Retinal fundus photograph: 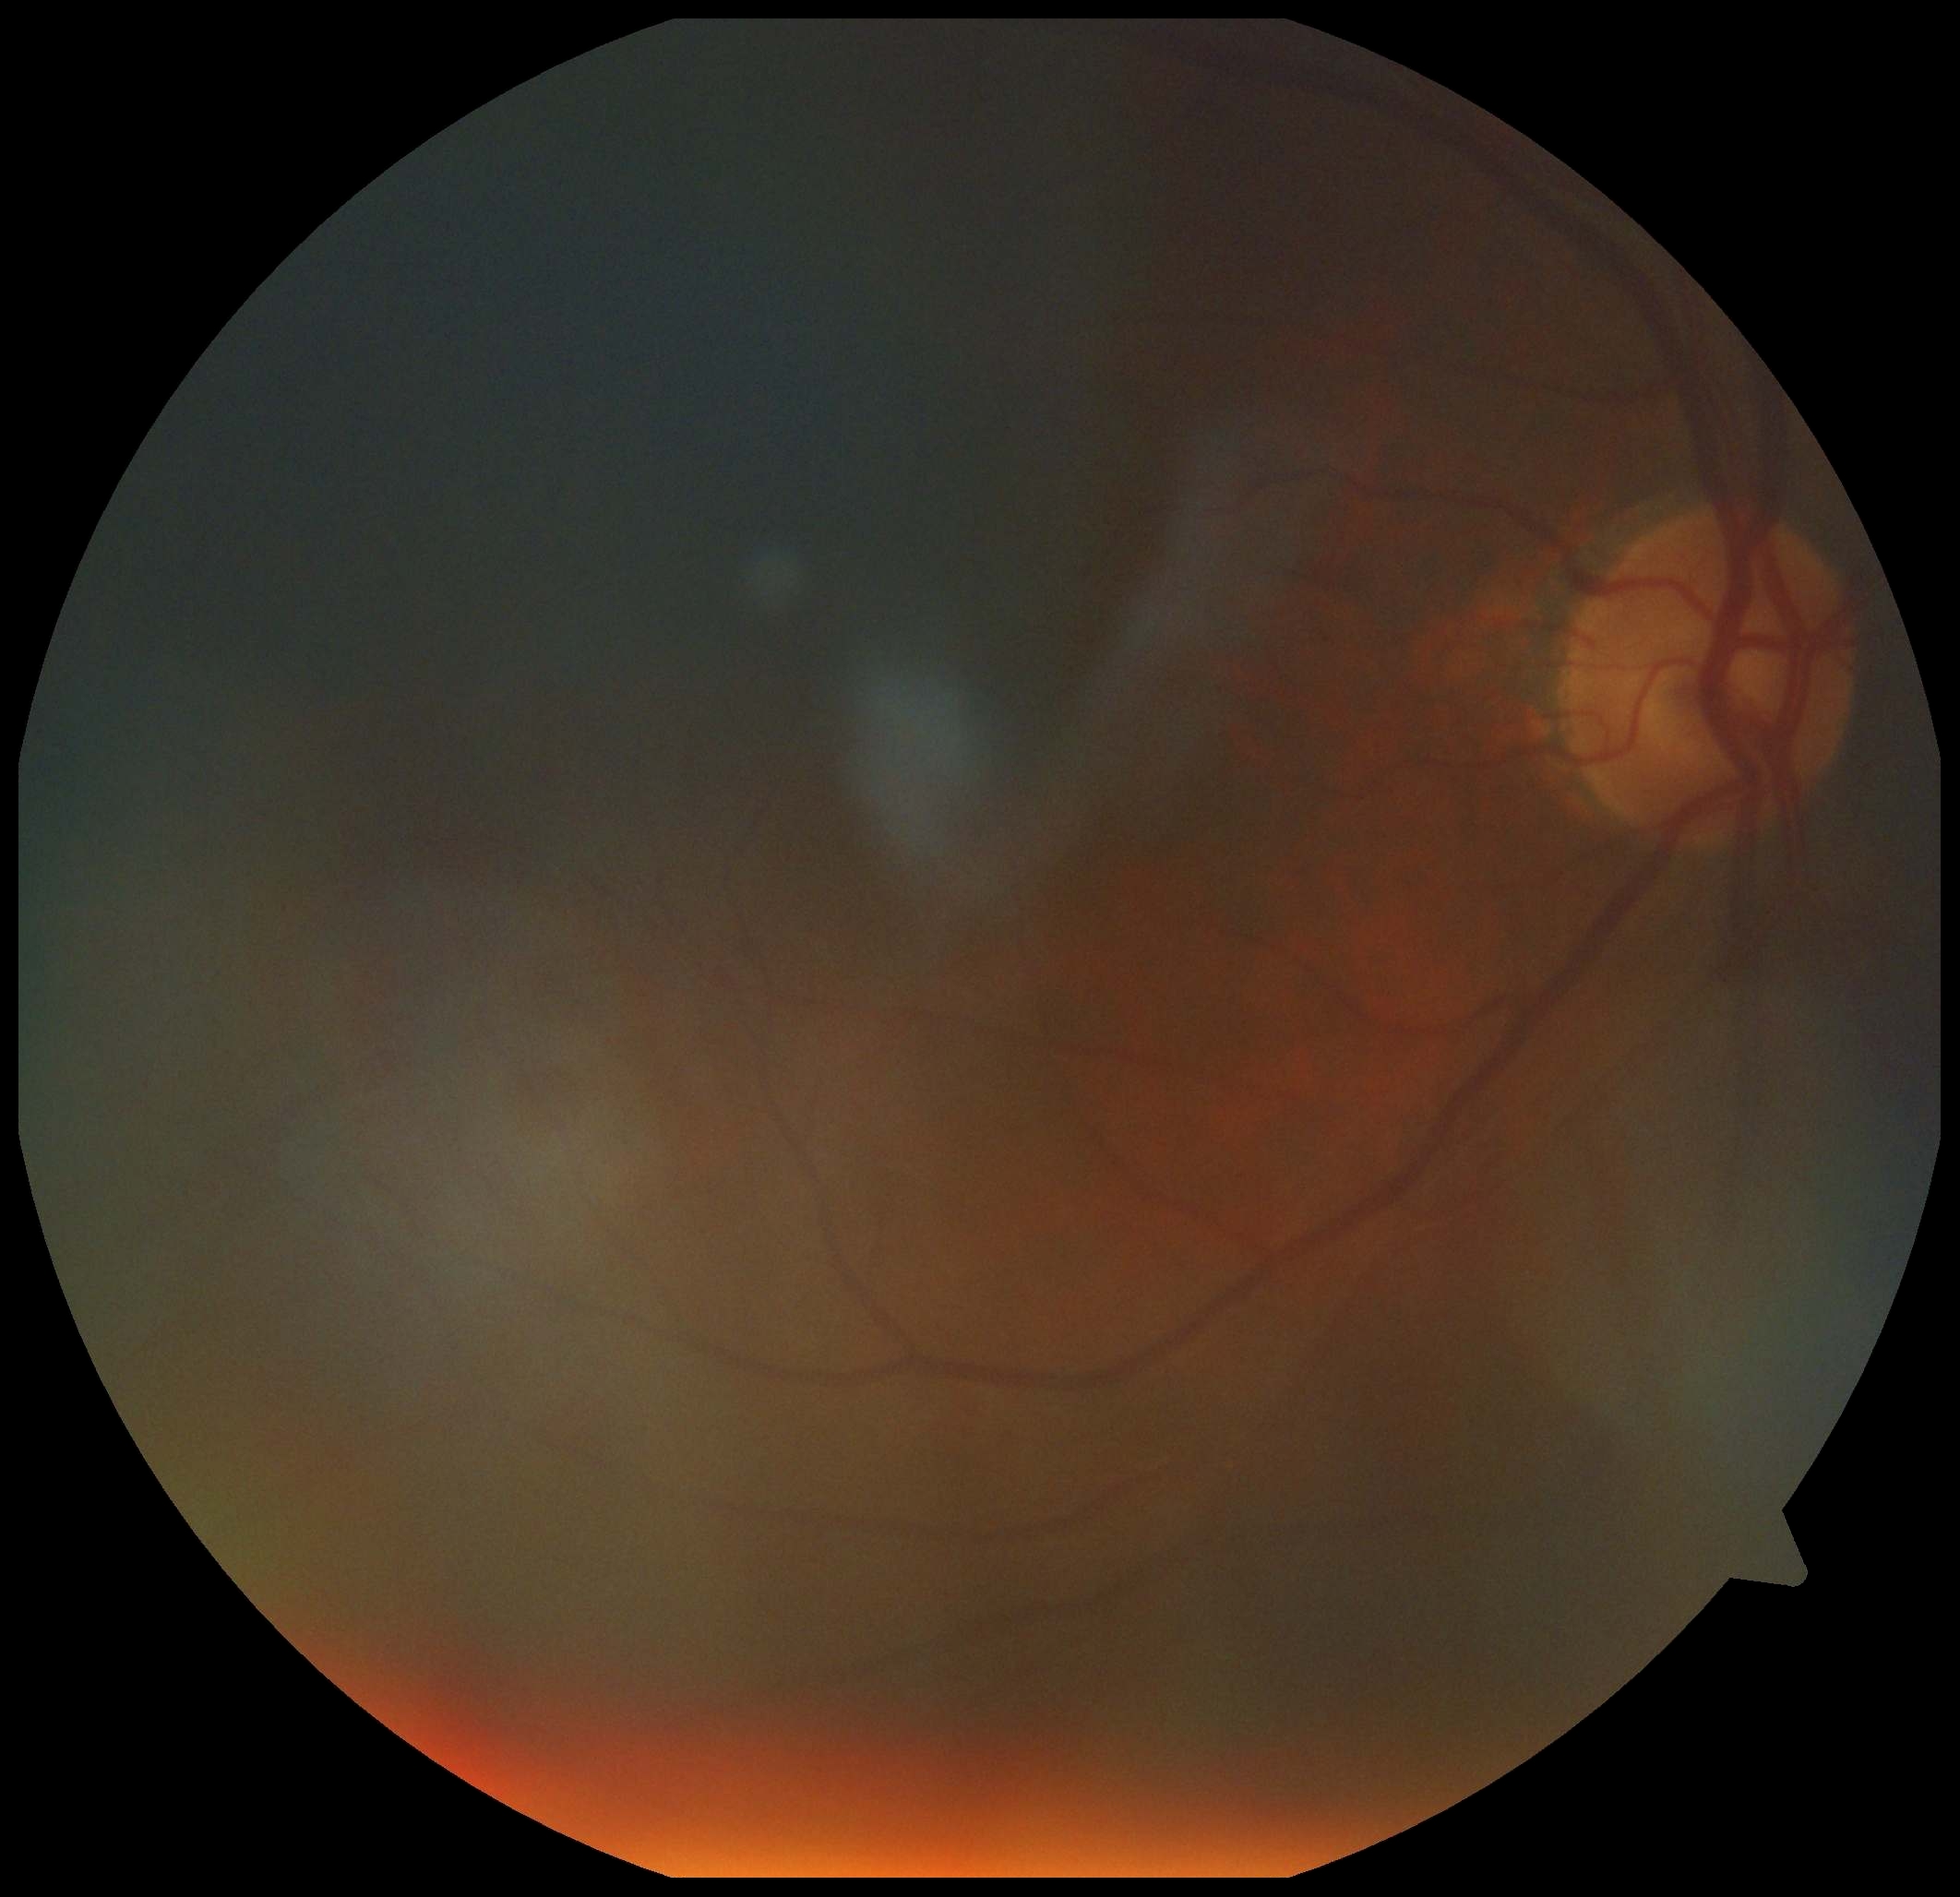

DR is ungradable due to poor image quality. Quality too poor to assess for DR.